Handheld portable fundus camera image: 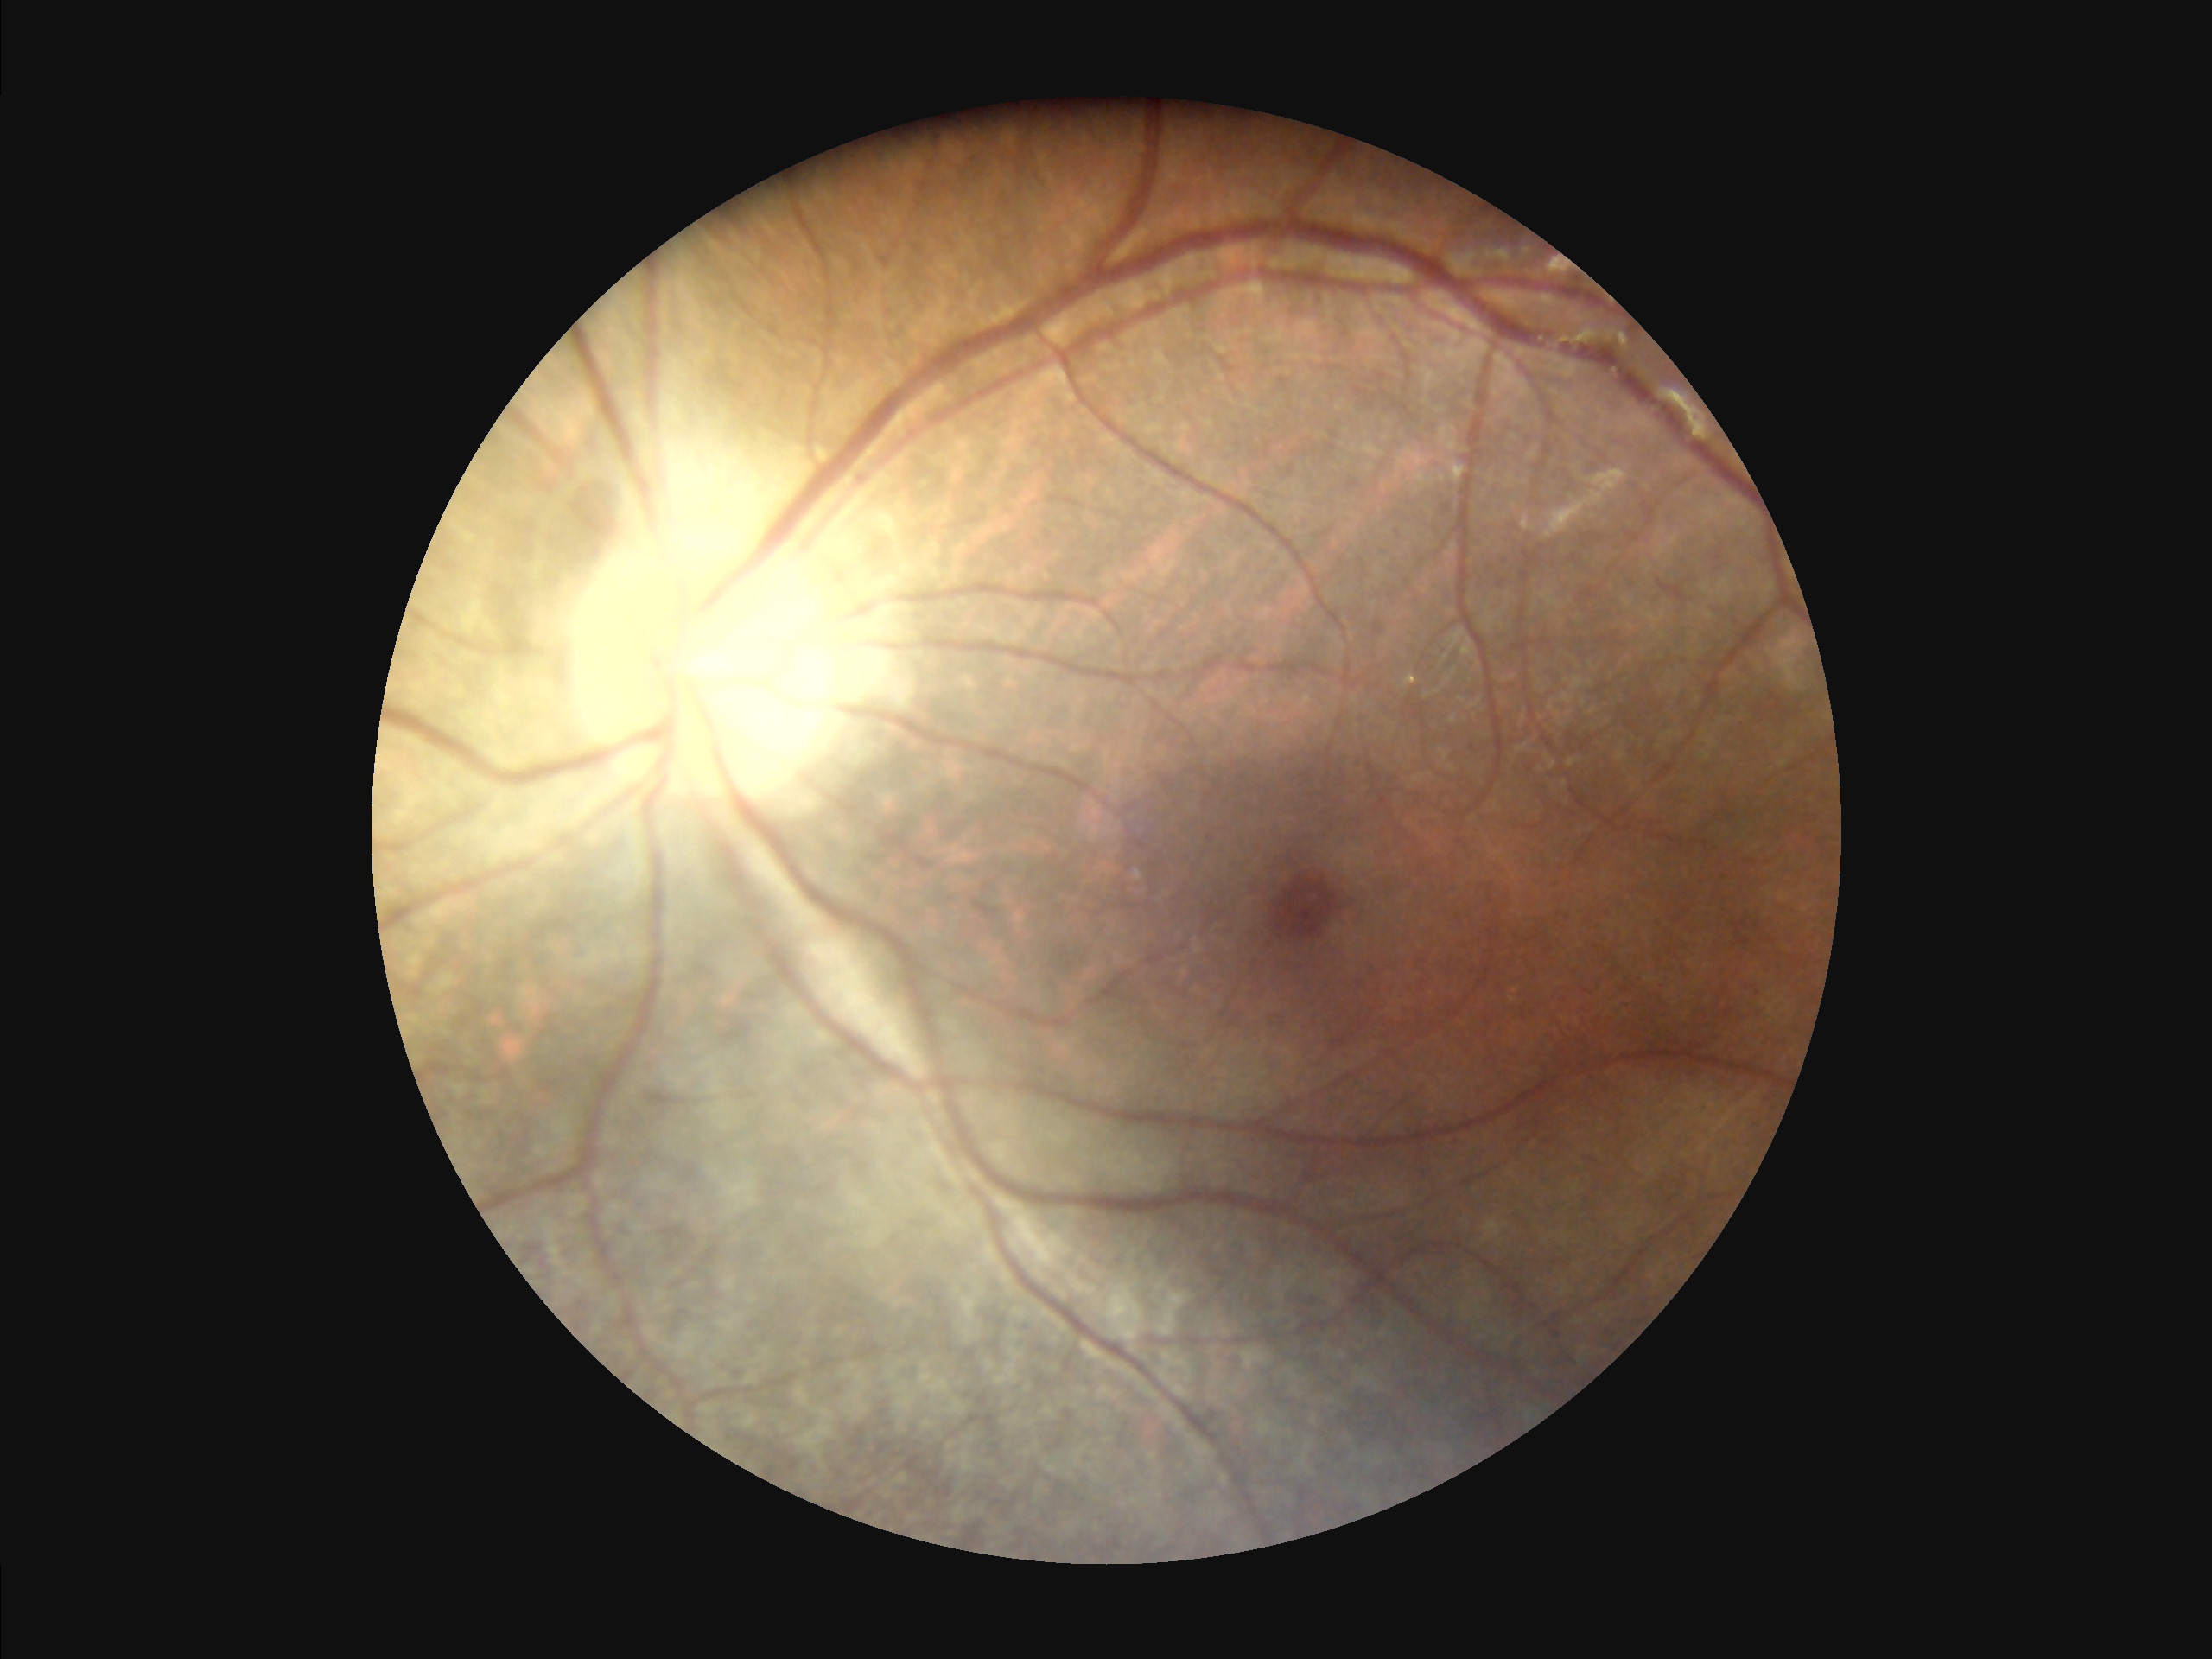
Quality grading: focus: good | illumination: suboptimal | overall: adequate | contrast: satisfactory.